Infant wide-field fundus photograph:
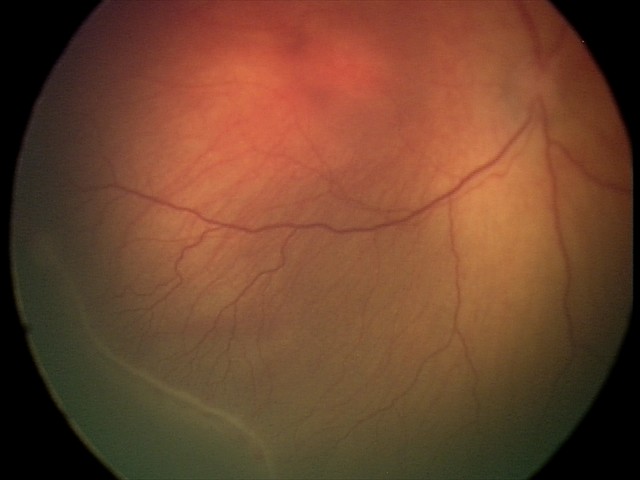 Plus disease absent.
Examination diagnosed as retinopathy of prematurity (ROP) stage 2.